Wide-field contact fundus photograph of an infant. Camera: Natus RetCam Envision (130° FOV). 1440 by 1080 pixels: 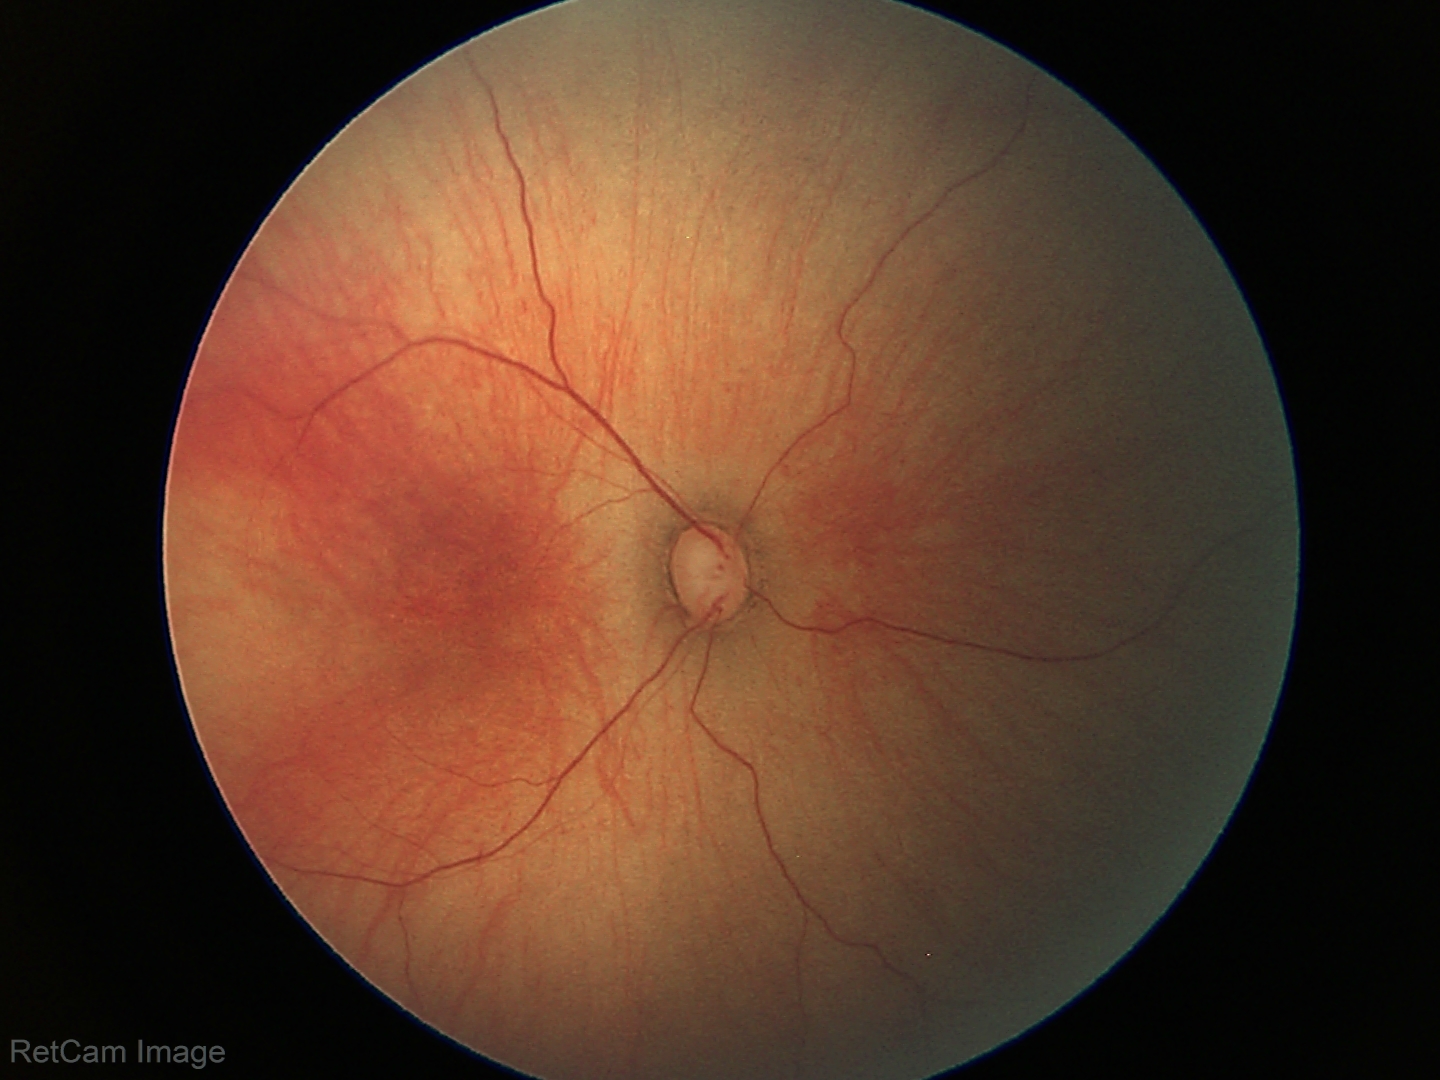

Impression = normal